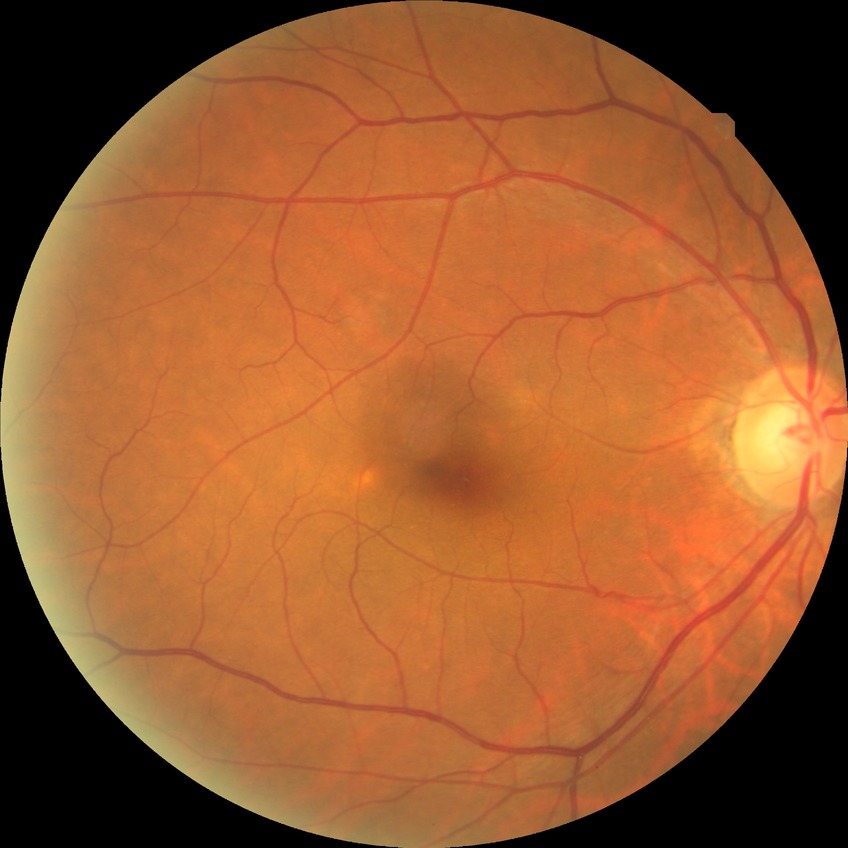
diabetic retinopathy (DR): NDR (no diabetic retinopathy).